CFP. 2089 x 1764 pixels: 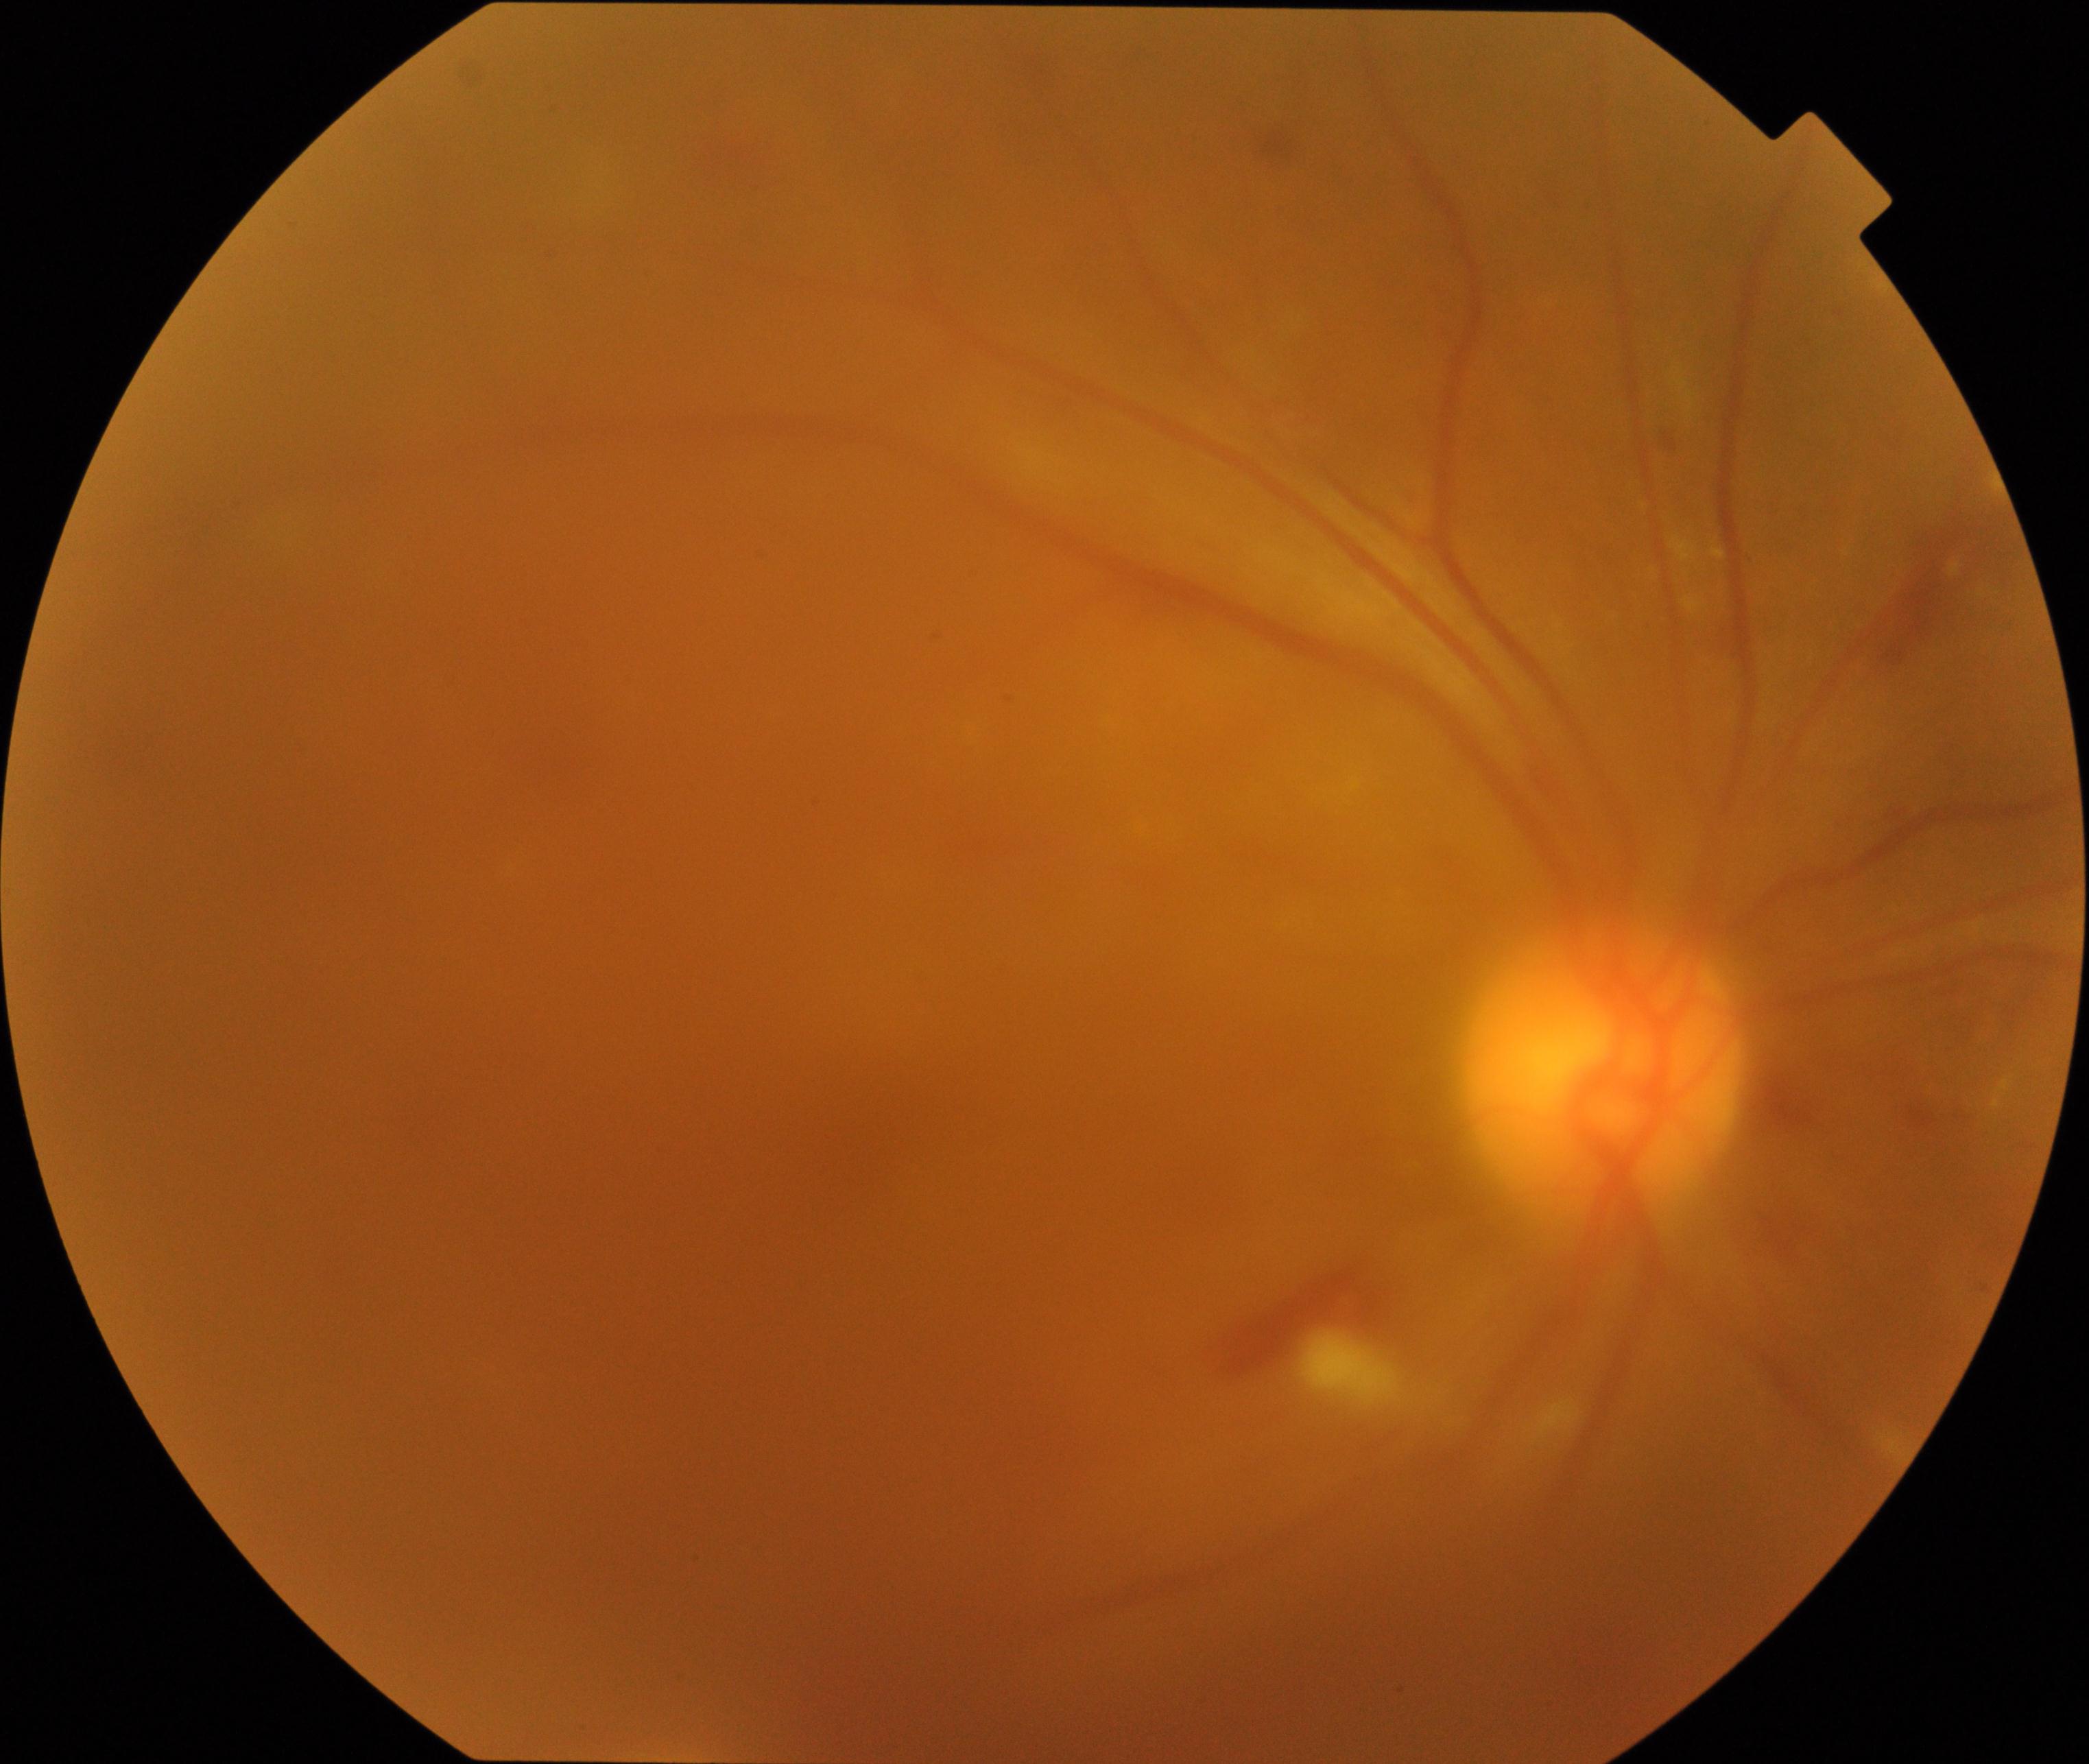 Image is blurred; retinal landmarks are largely obscured. Suspected proliferative diabetic retinopathy.